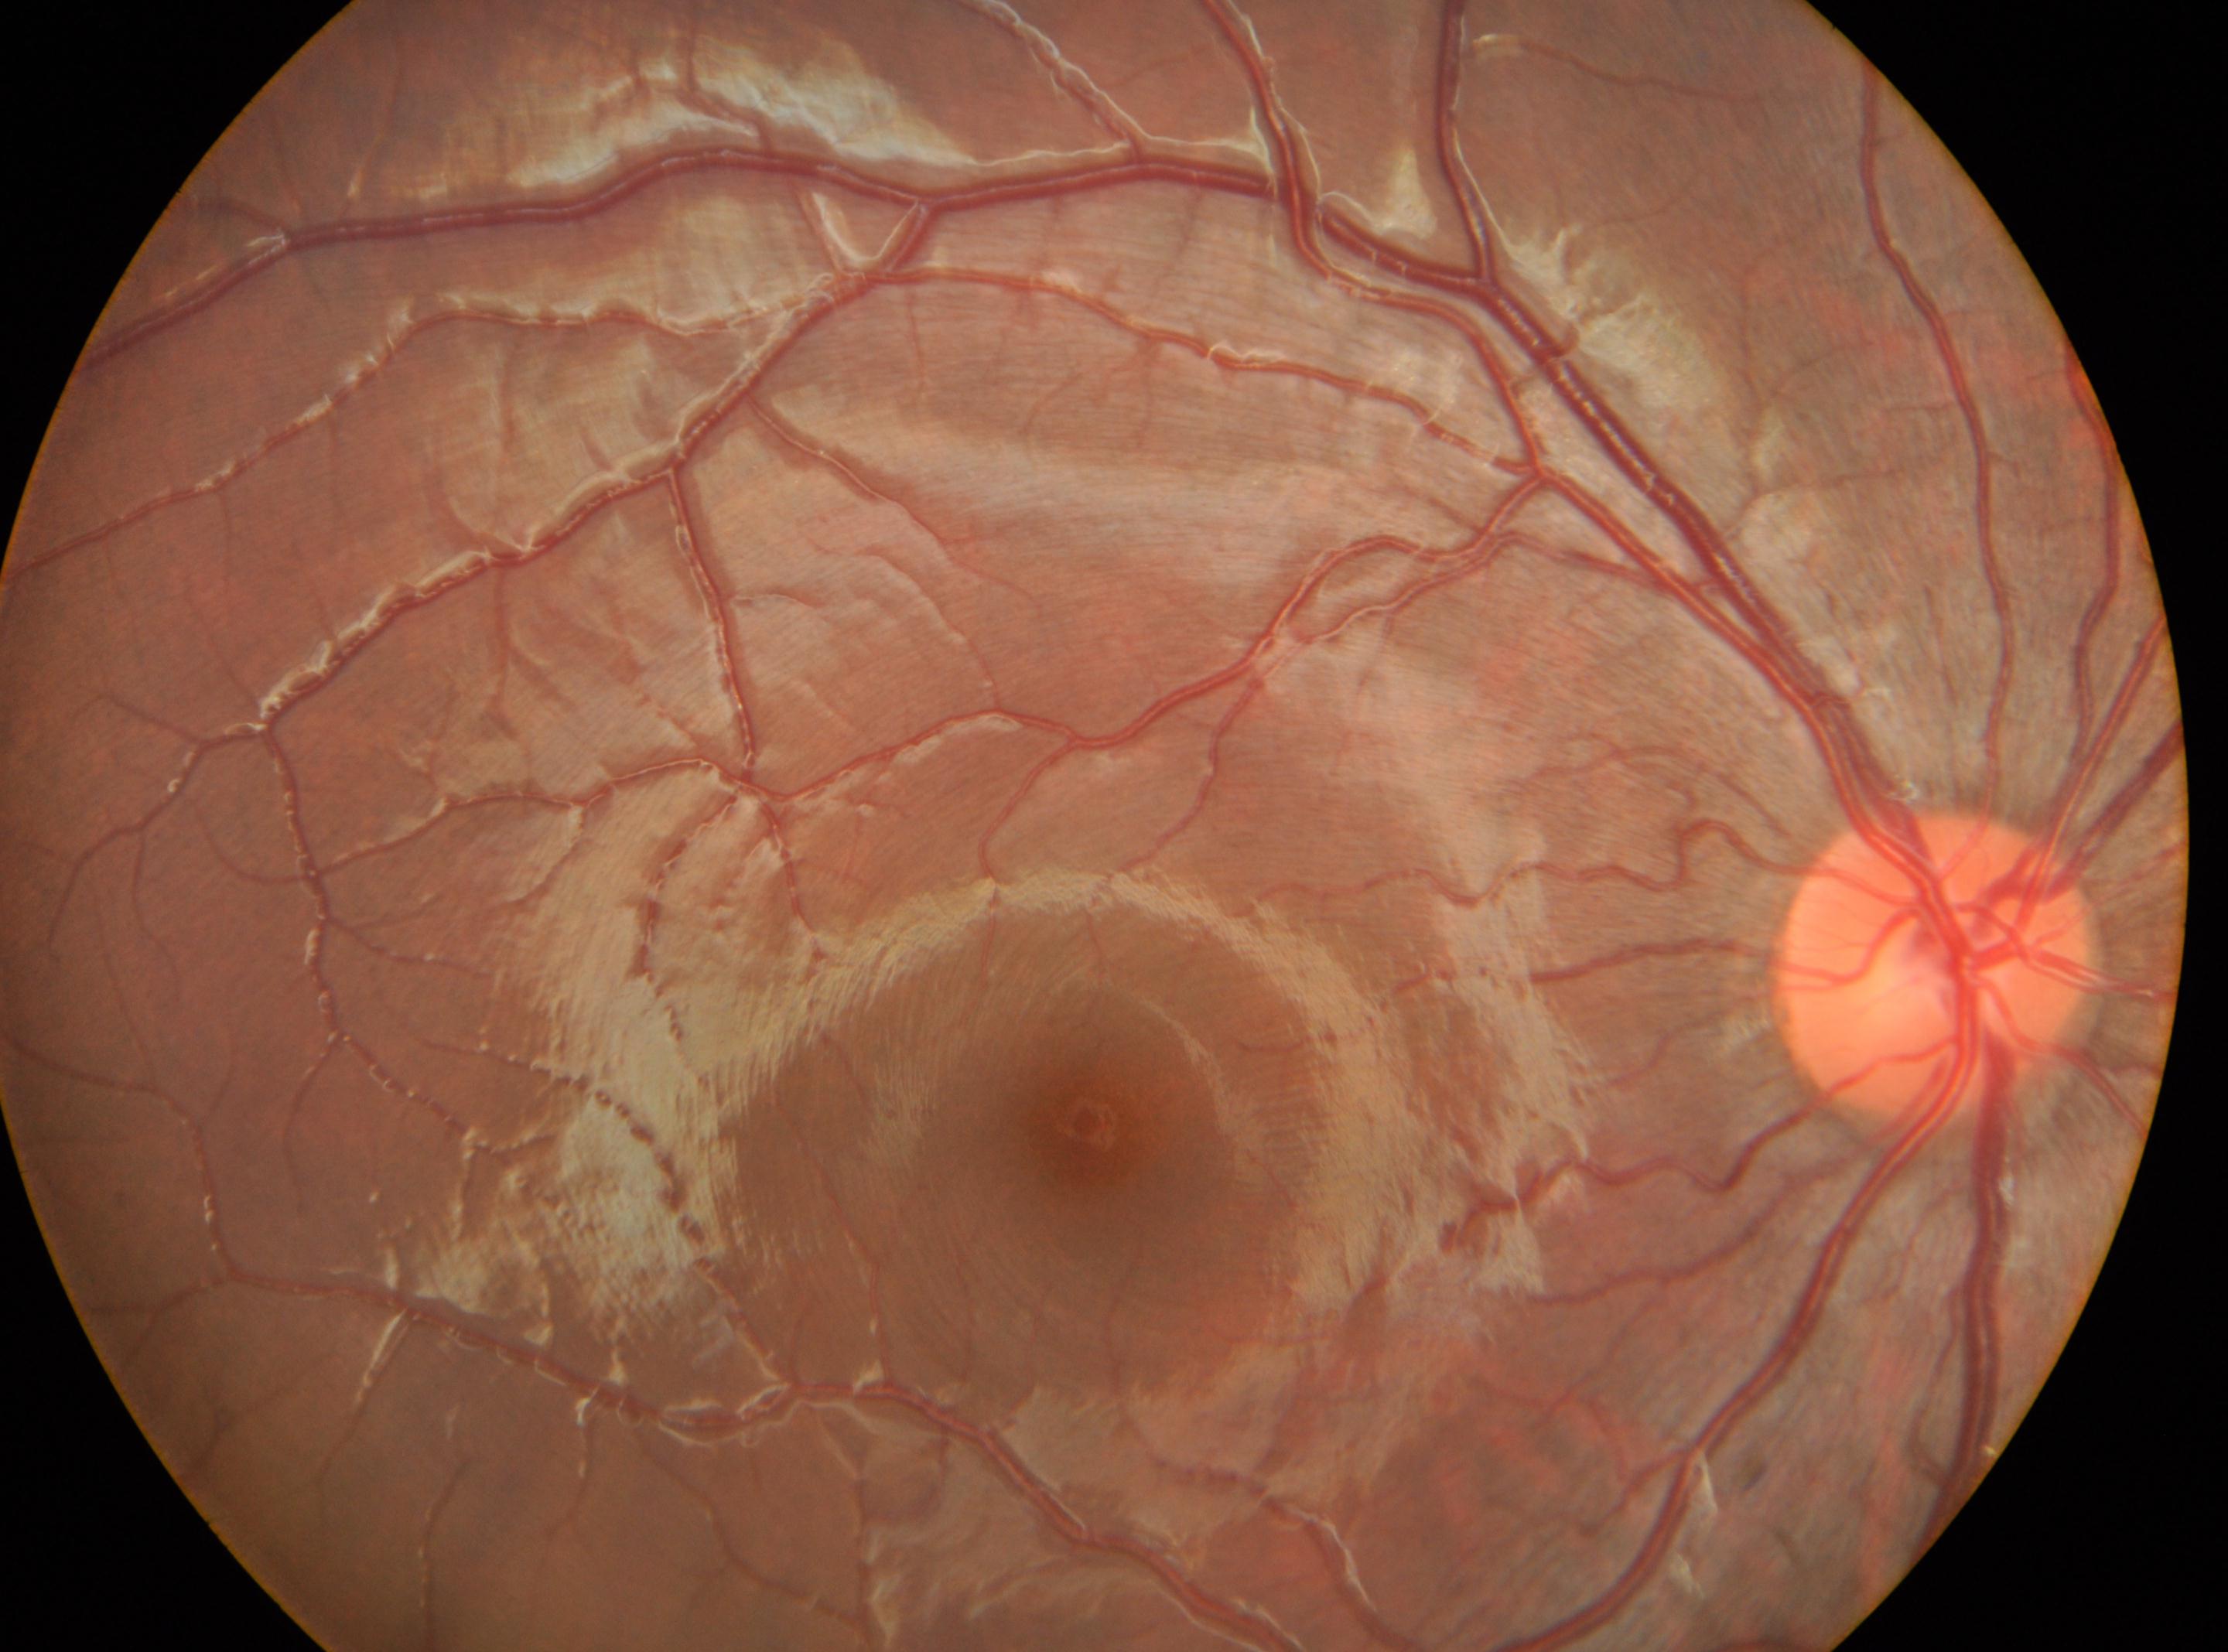
The macula center is at [1082, 1128].
The optic disc is at [1932, 964].
This is the oculus dexter.
DR stage: no apparent diabetic retinopathy (grade 0).